Modified Davis grading; posterior pole color fundus photograph — 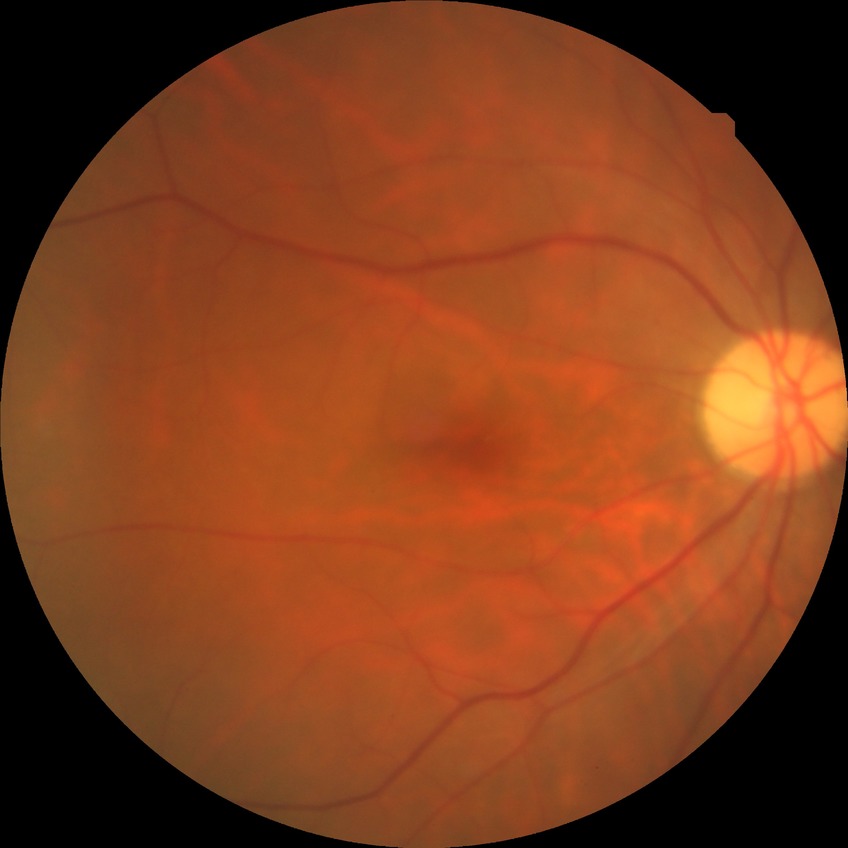 Diabetic retinopathy (DR): no diabetic retinopathy (NDR).